240x240
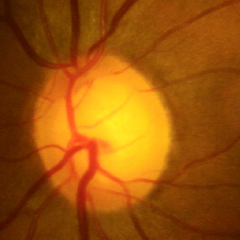 Fundus appearance consistent with no glaucomatous findings.